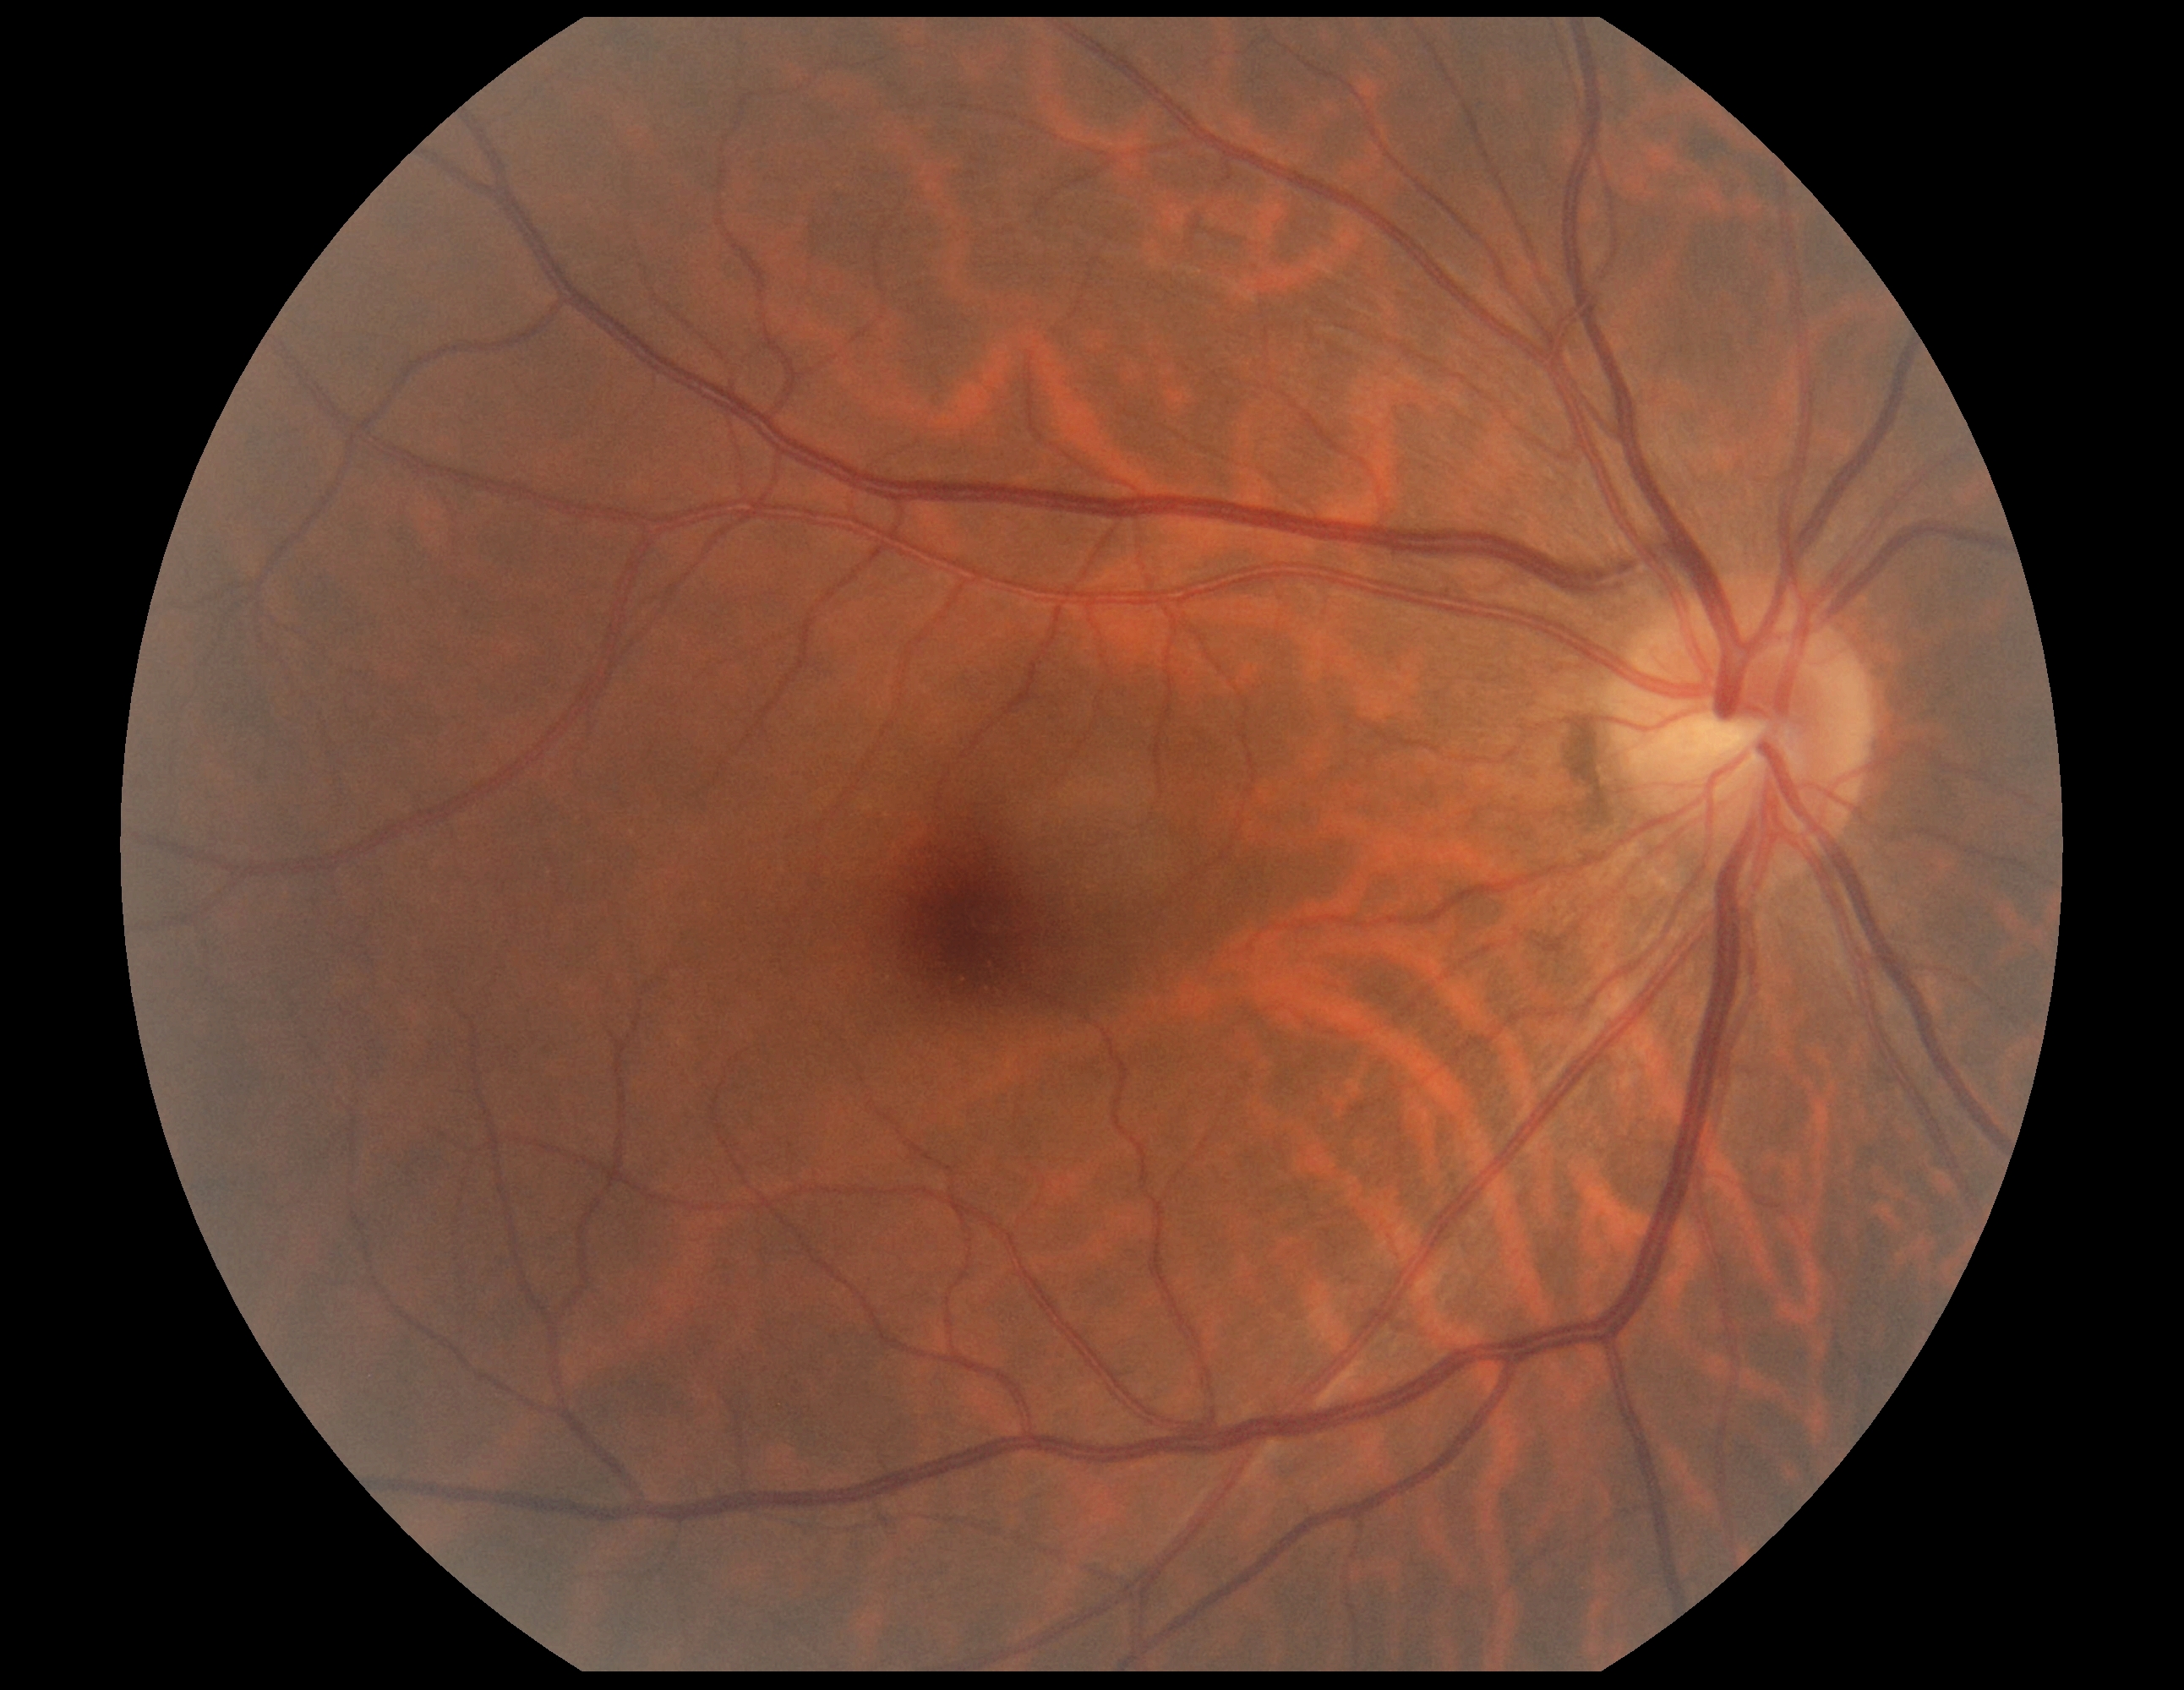

{
  "dr_grade": "grade 0 — no visible signs of diabetic retinopathy",
  "dr_impression": "no DR findings"
}